848x848px, diabetic retinopathy graded by the modified Davis classification: 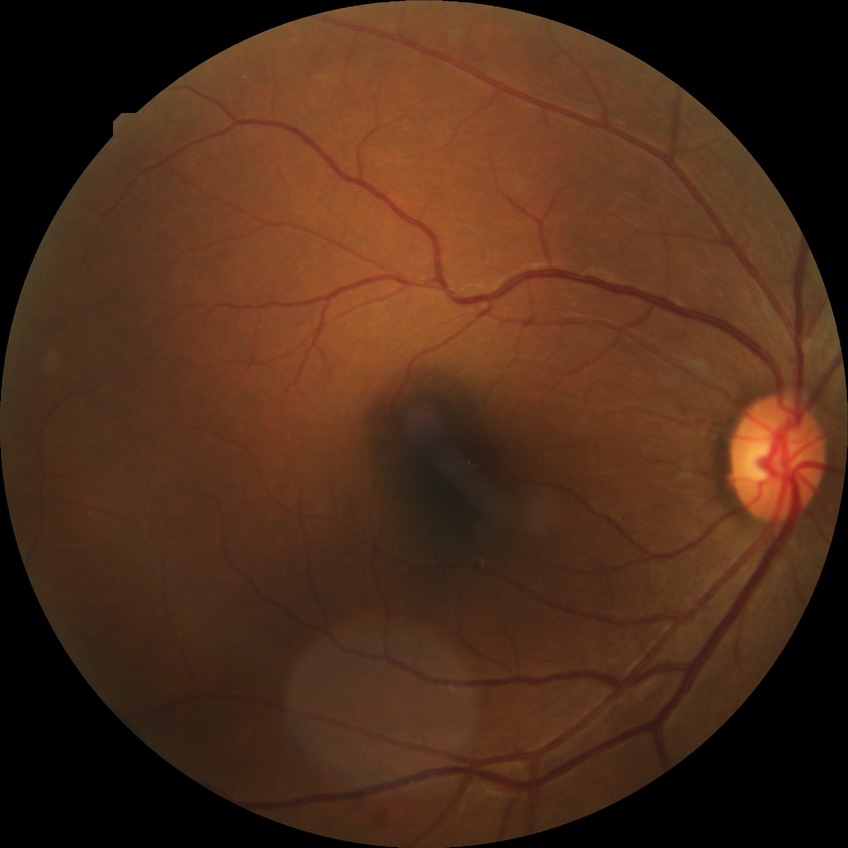 Davis DR grade: PPDR. The retinopathy is classified as non-proliferative diabetic retinopathy.